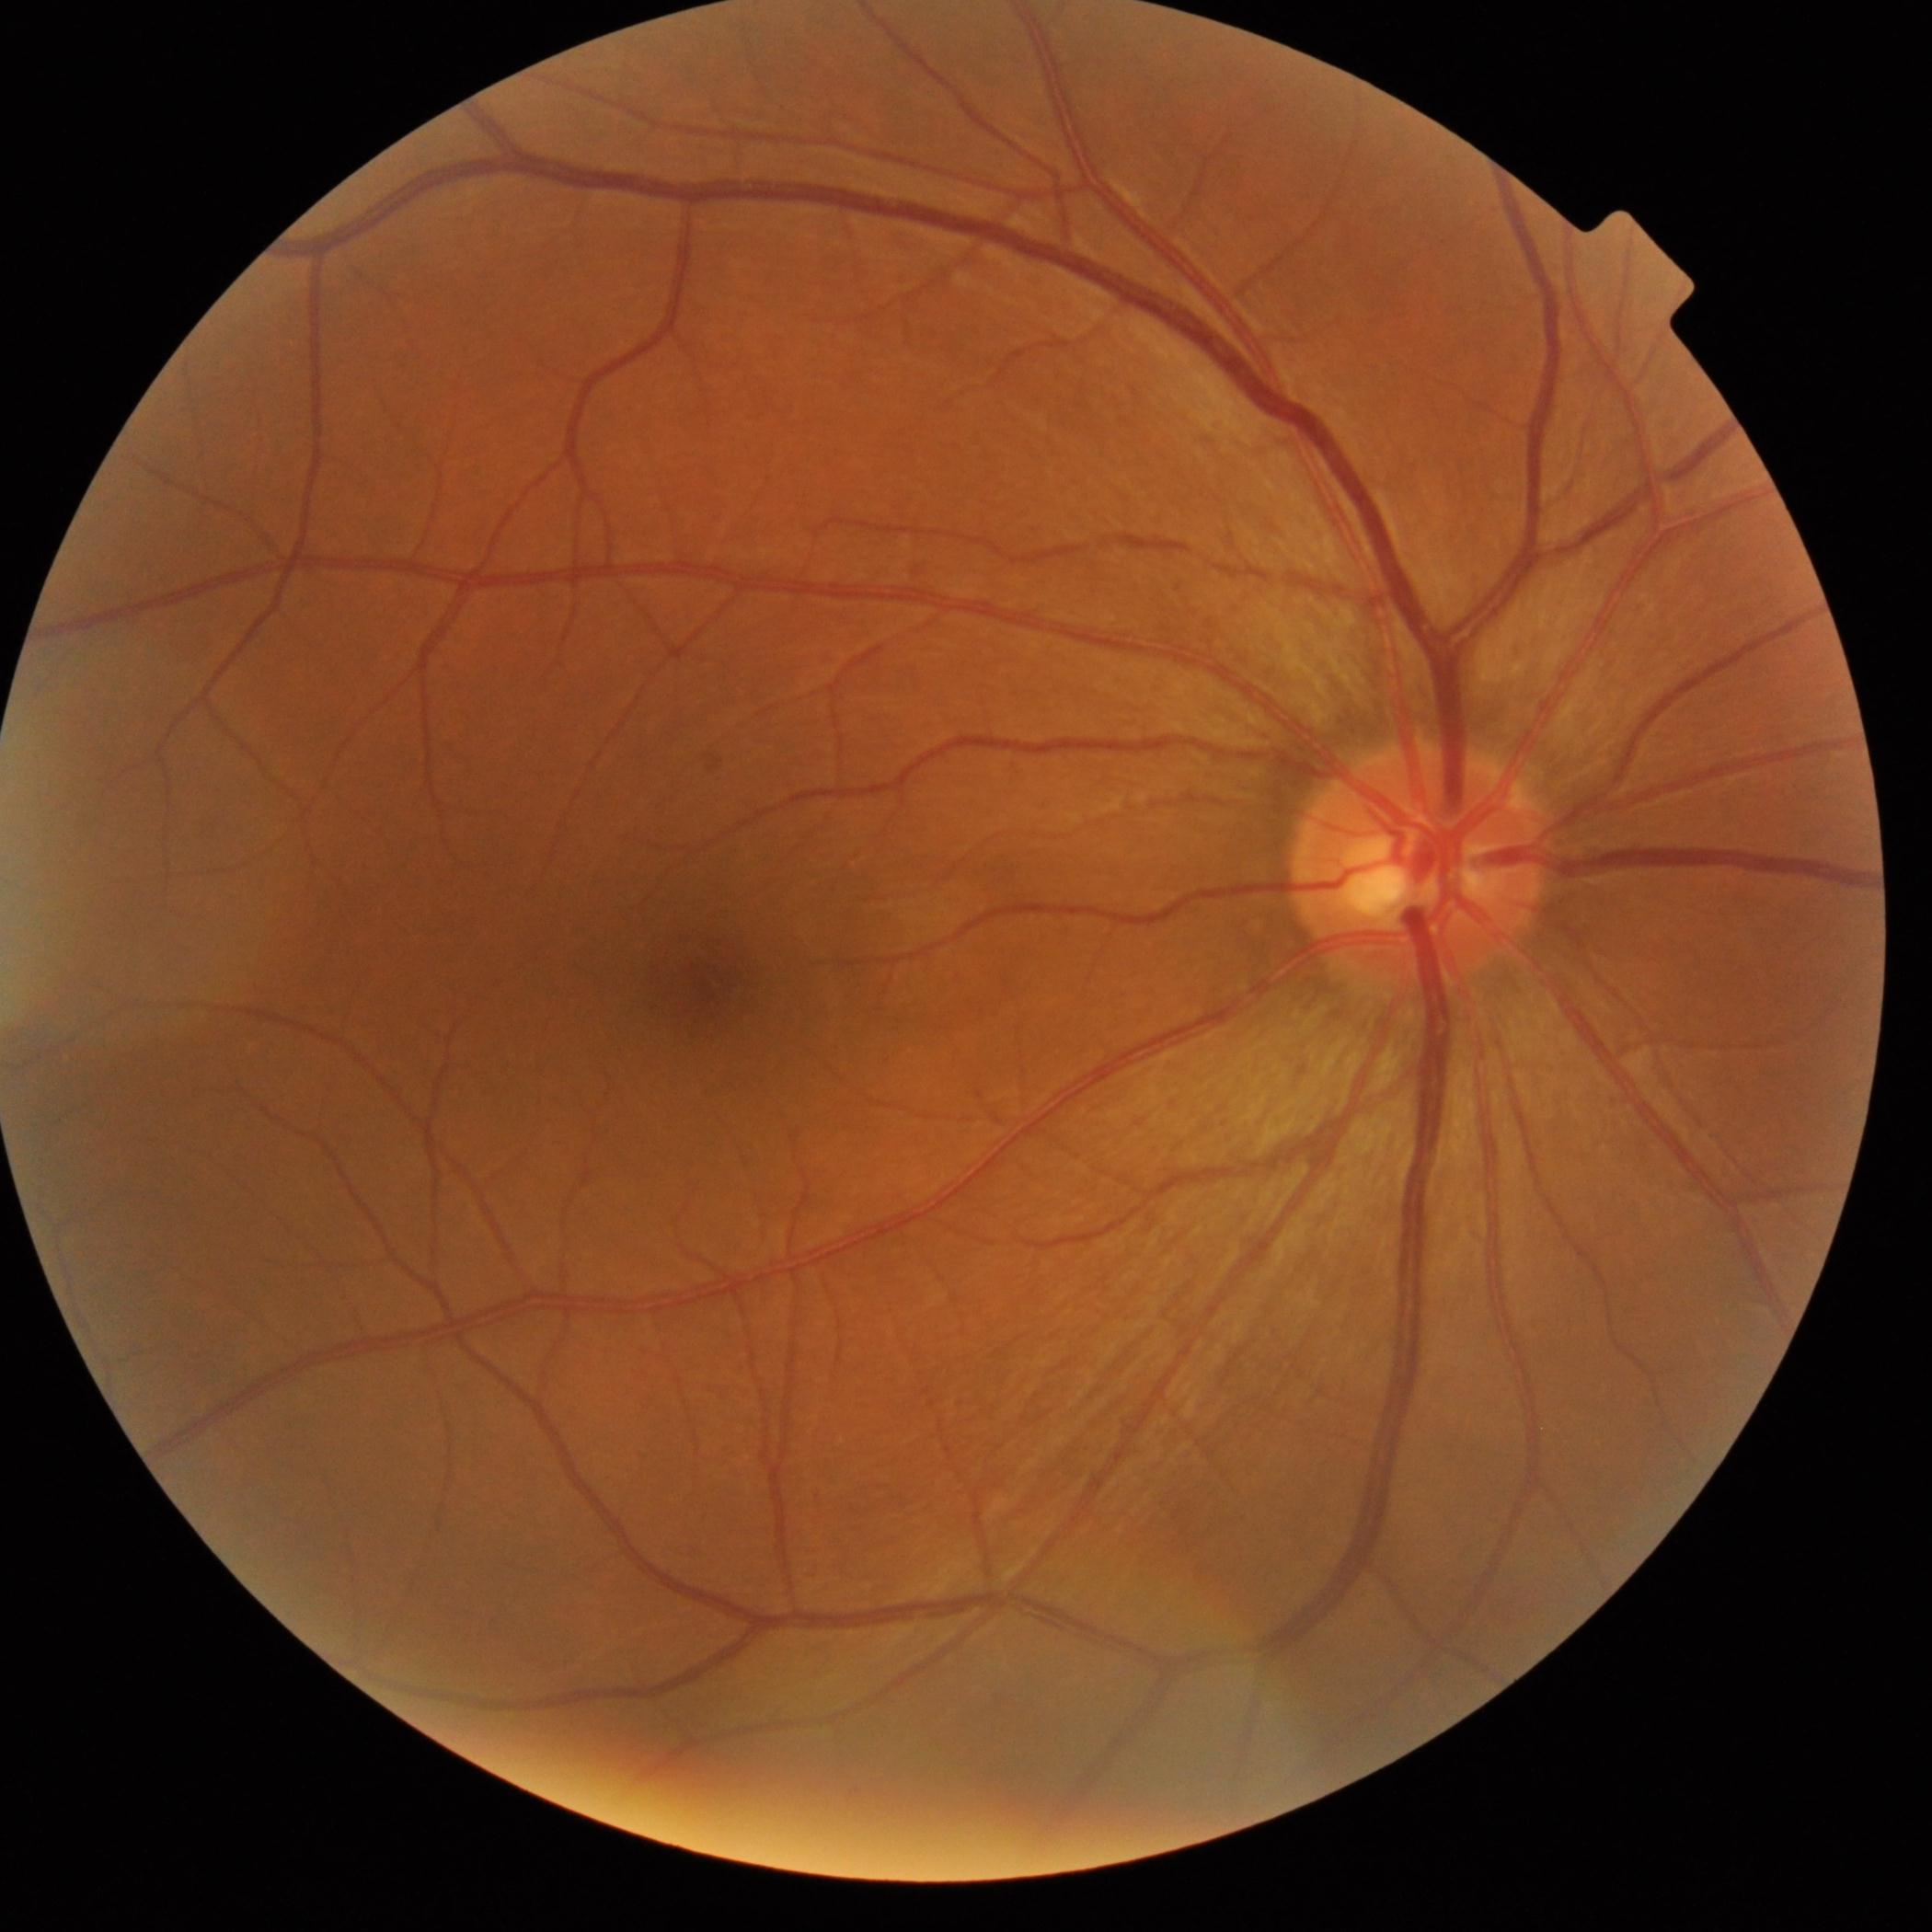

{"dr_grade": "no apparent retinopathy (0)"}